Infant wide-field fundus photograph
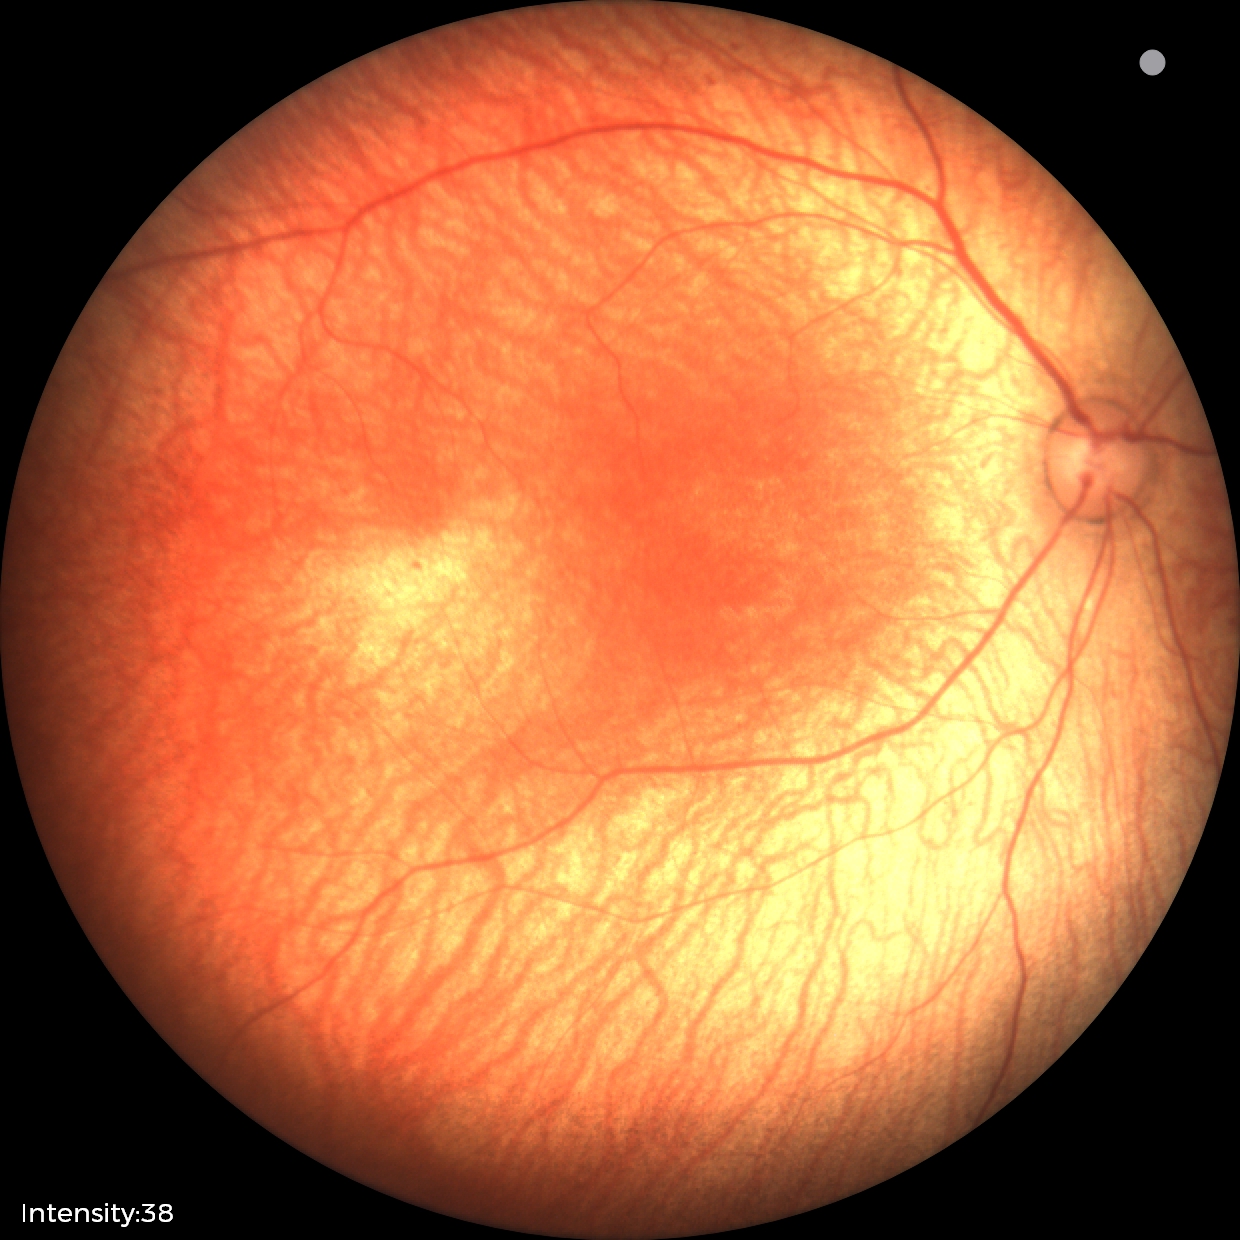 Screening examination with no abnormal retinal findings.